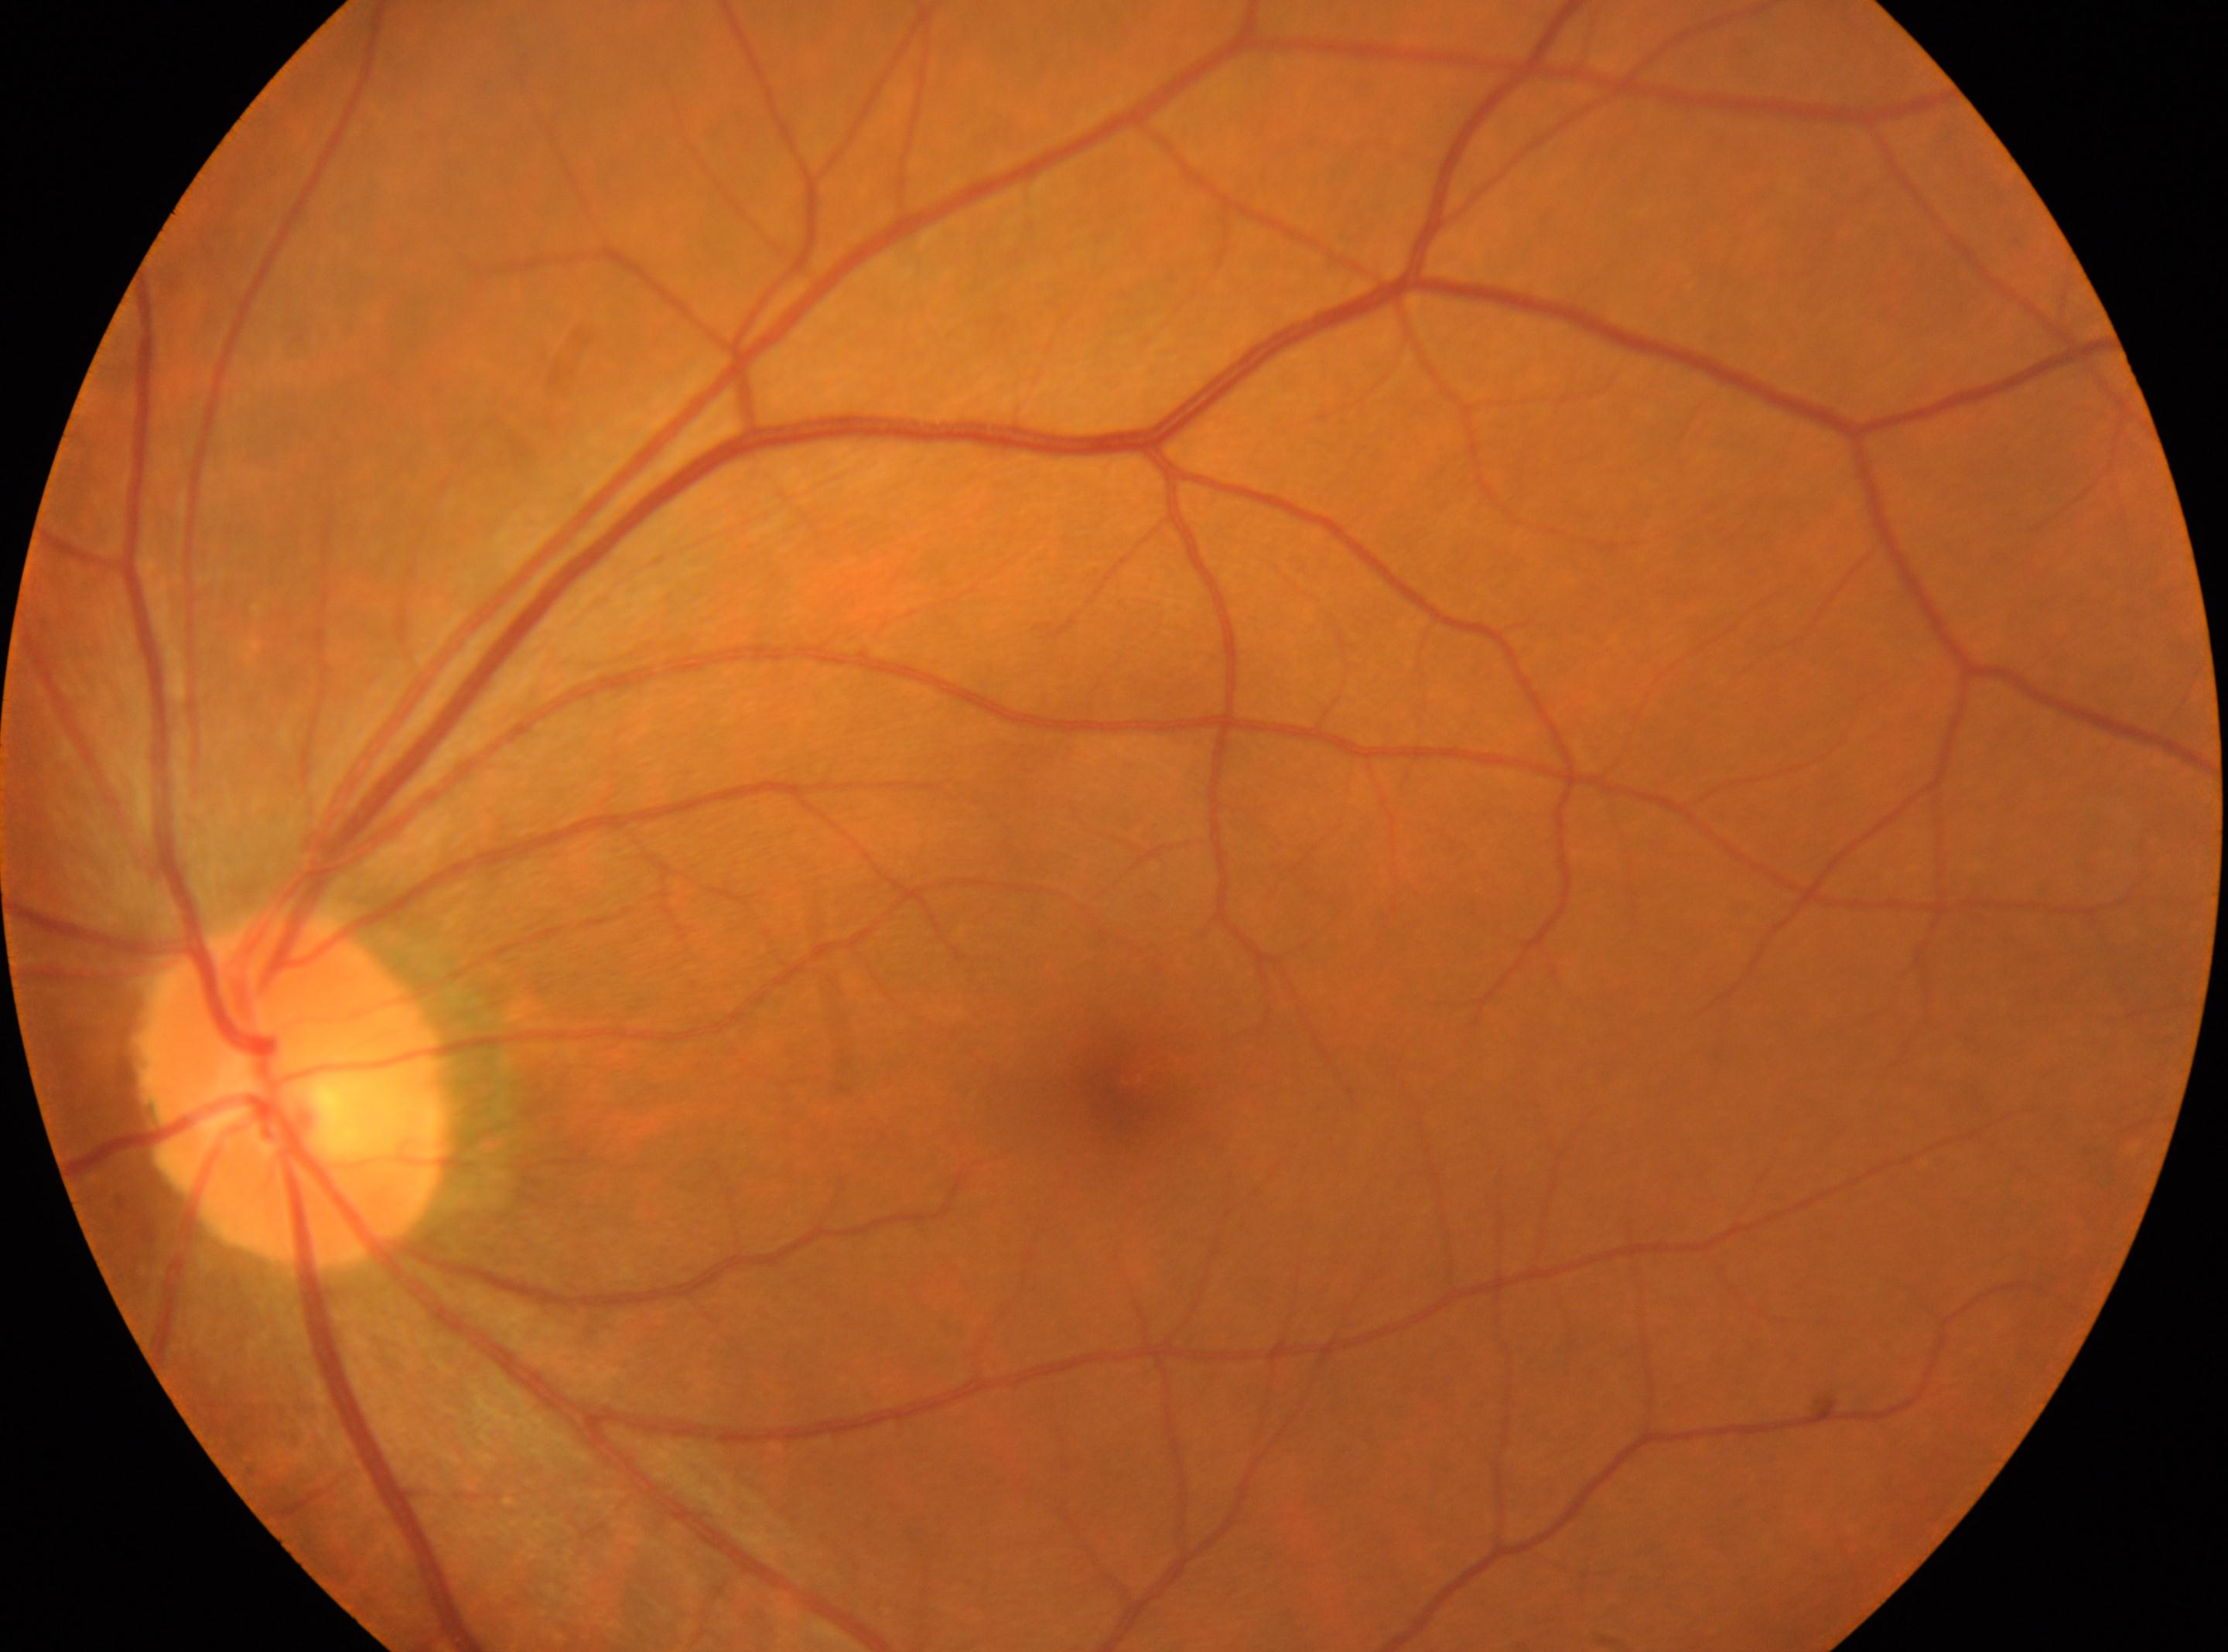
macular center@(x=1120, y=1084) | diabetic retinopathy severity@grade 0 (no apparent retinopathy) | the optic disc@(x=294, y=1089) | No apparent diabetic retinopathy | OS.